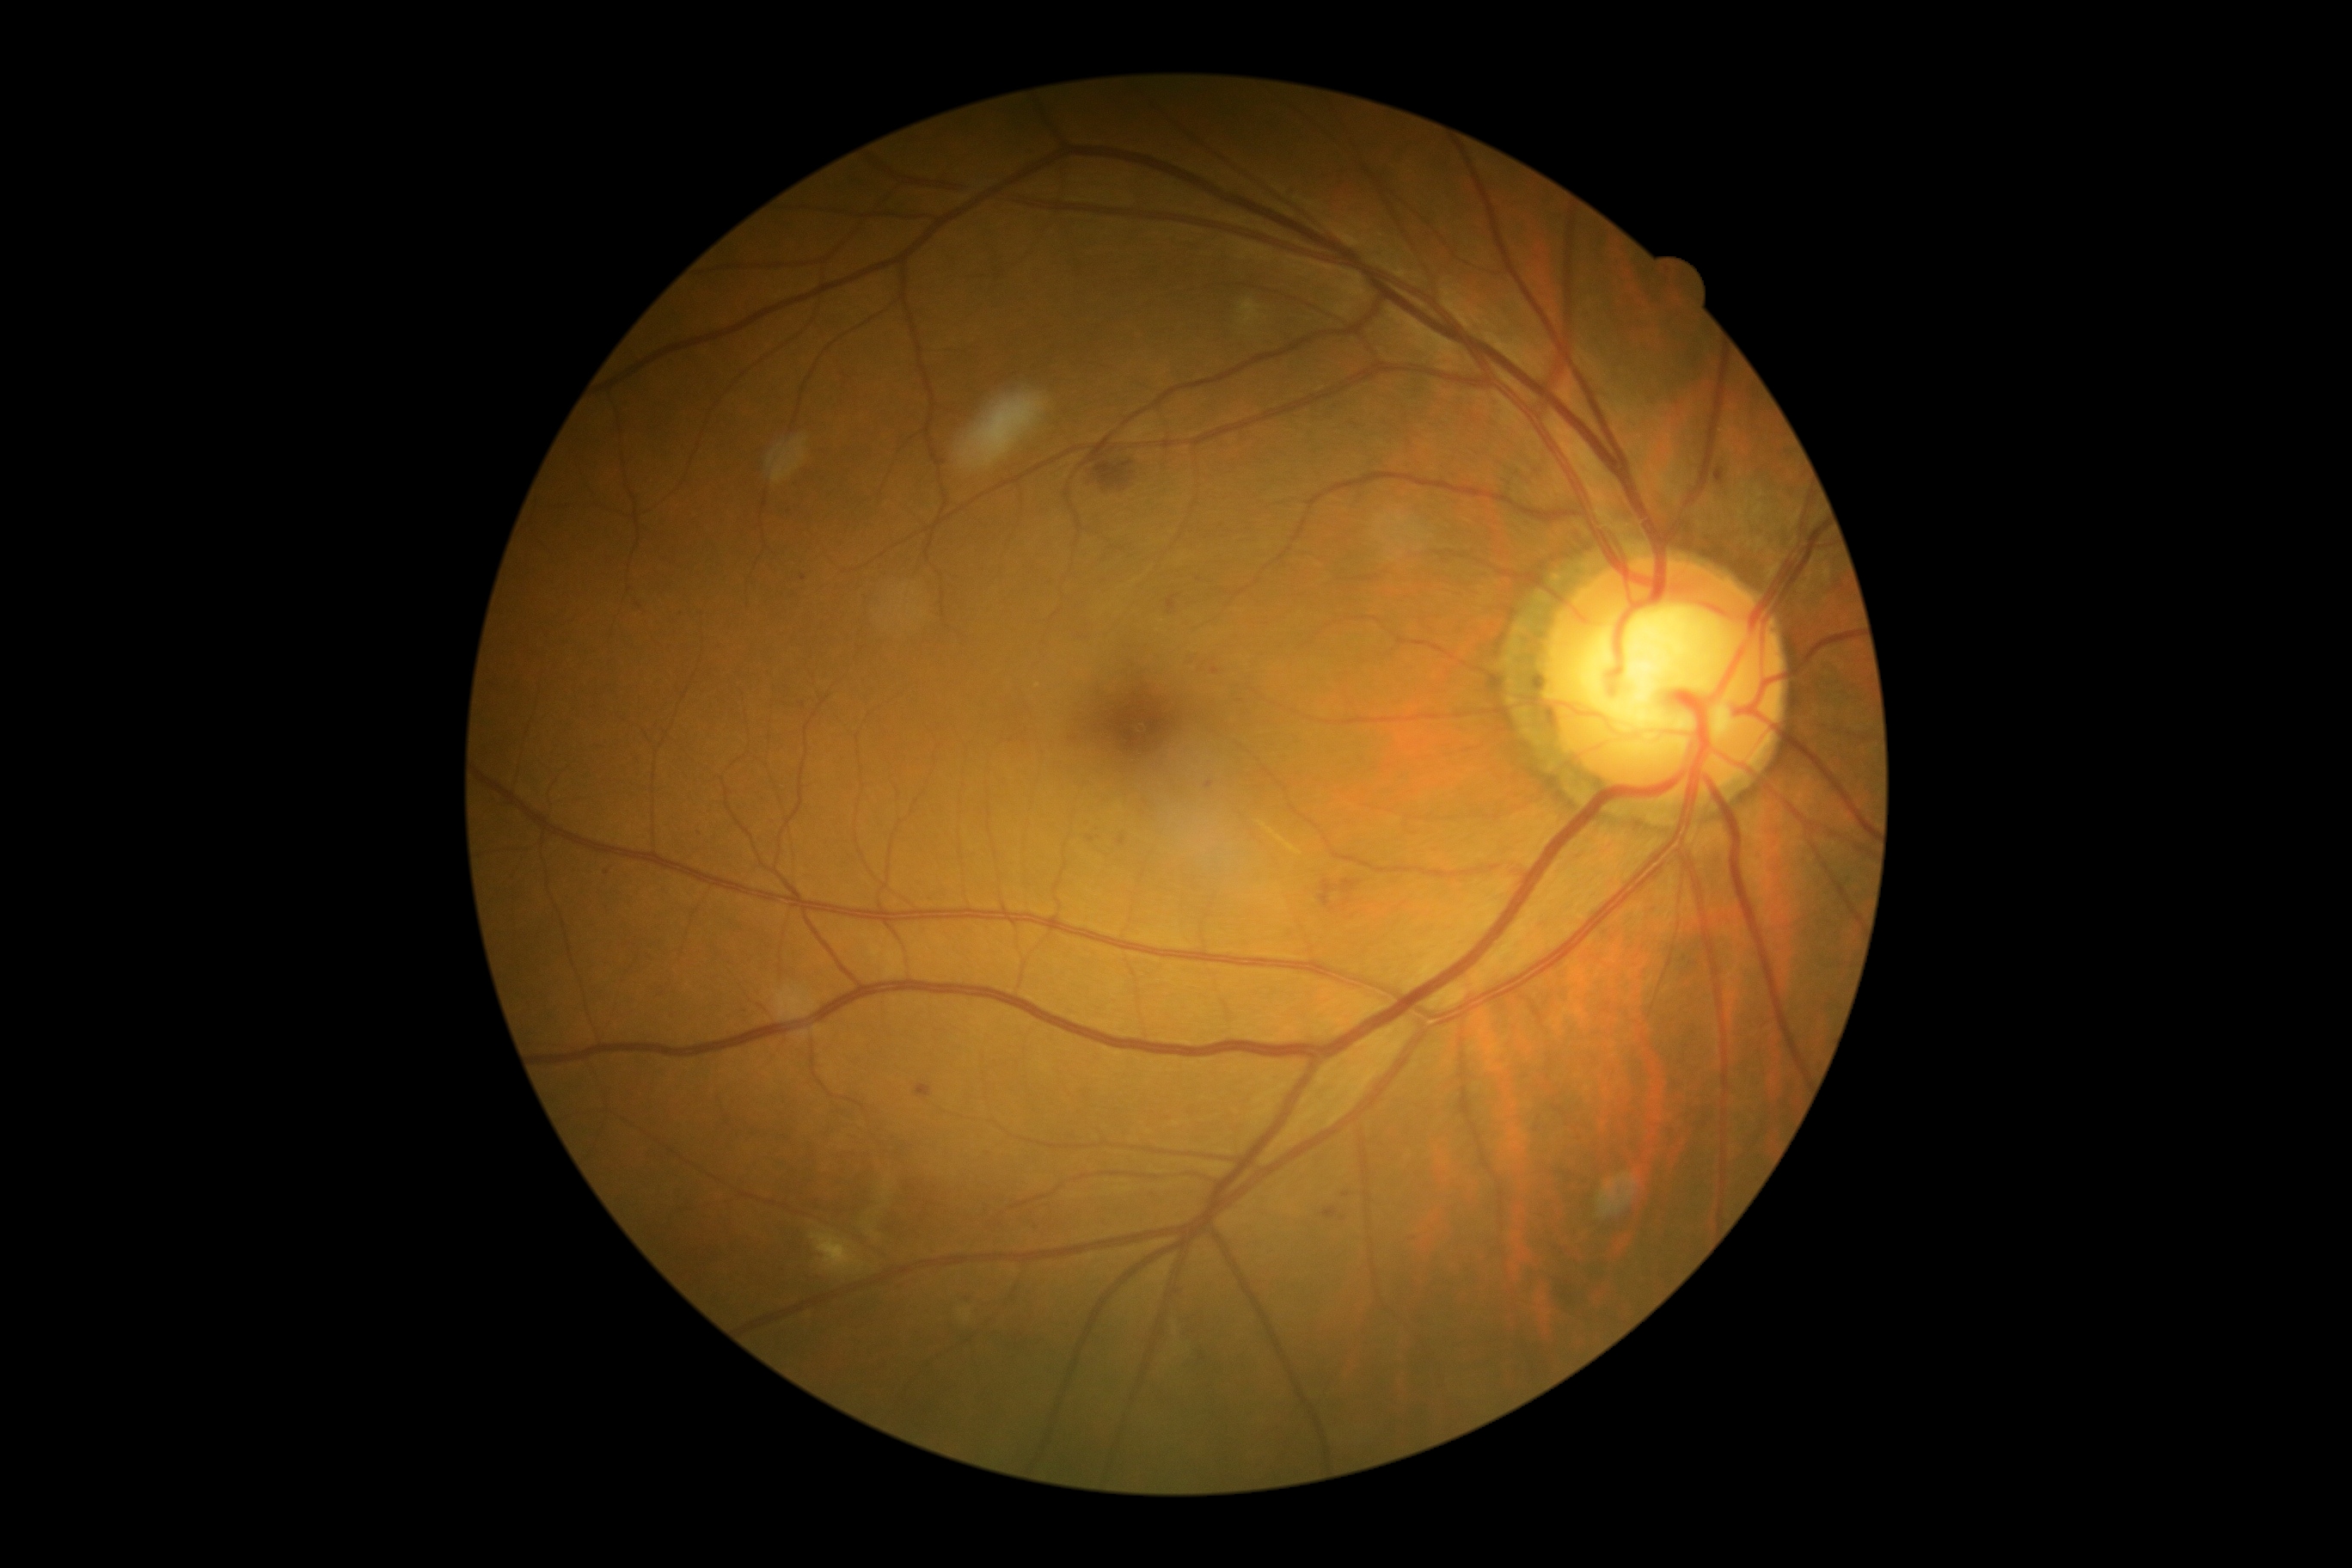

diabetic retinopathy (DR): grade 2.